Wide-field fundus image from infant ROP screening.
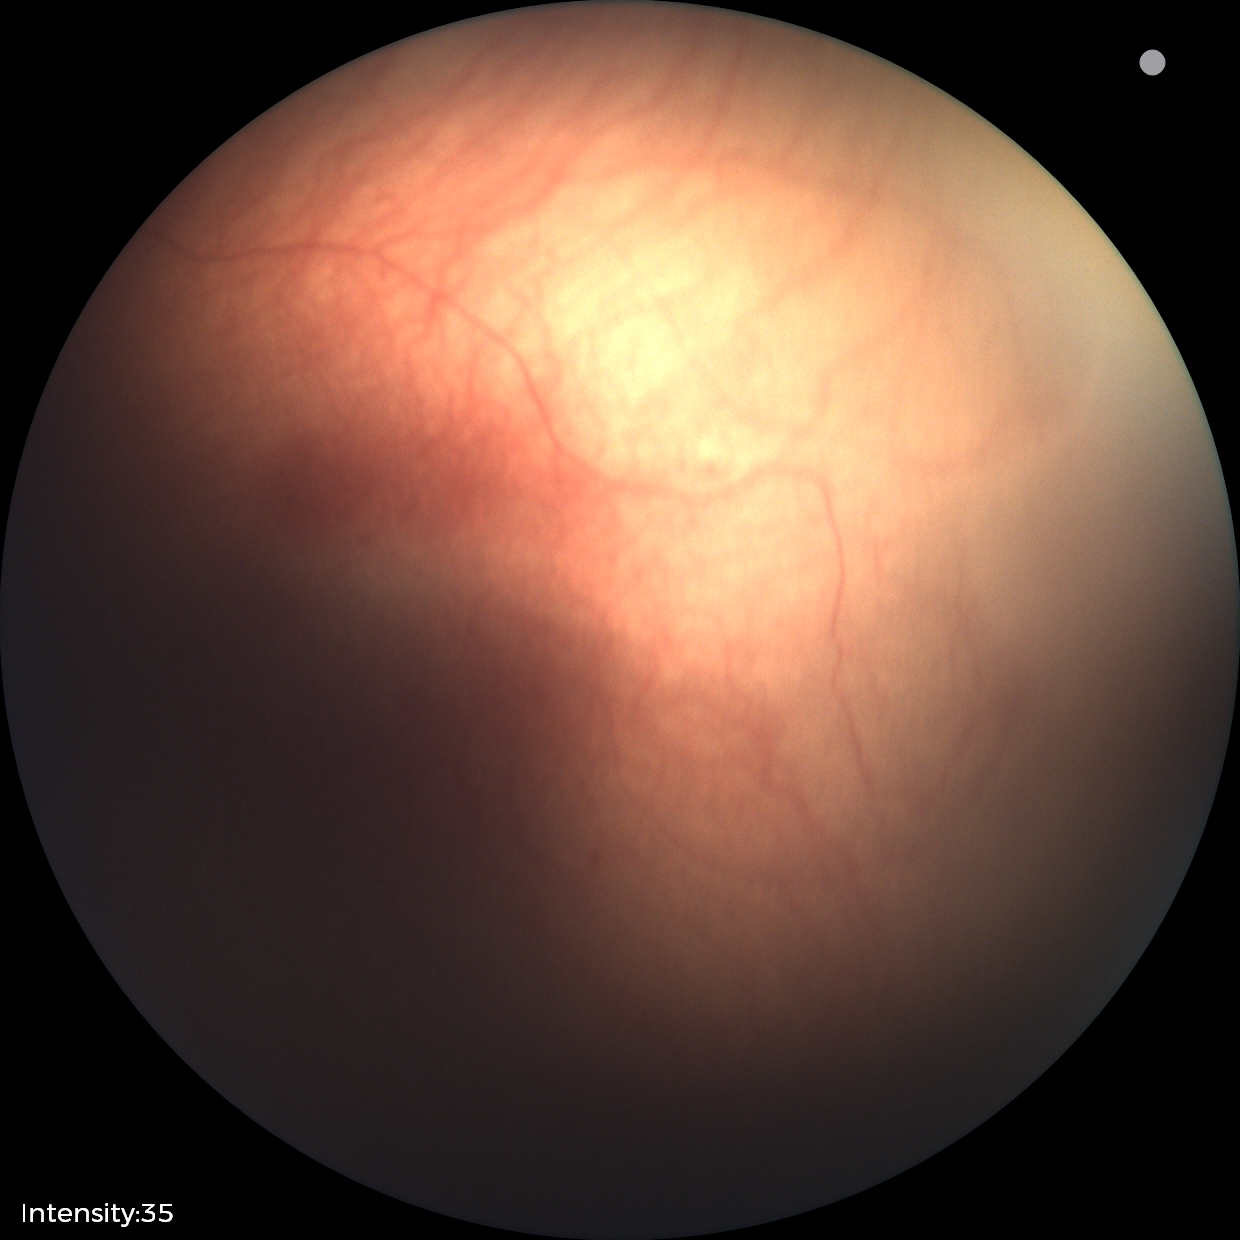
Without plus disease. Screening examination consistent with ROP stage 1.